Retinal fundus photograph. 2352x1568:
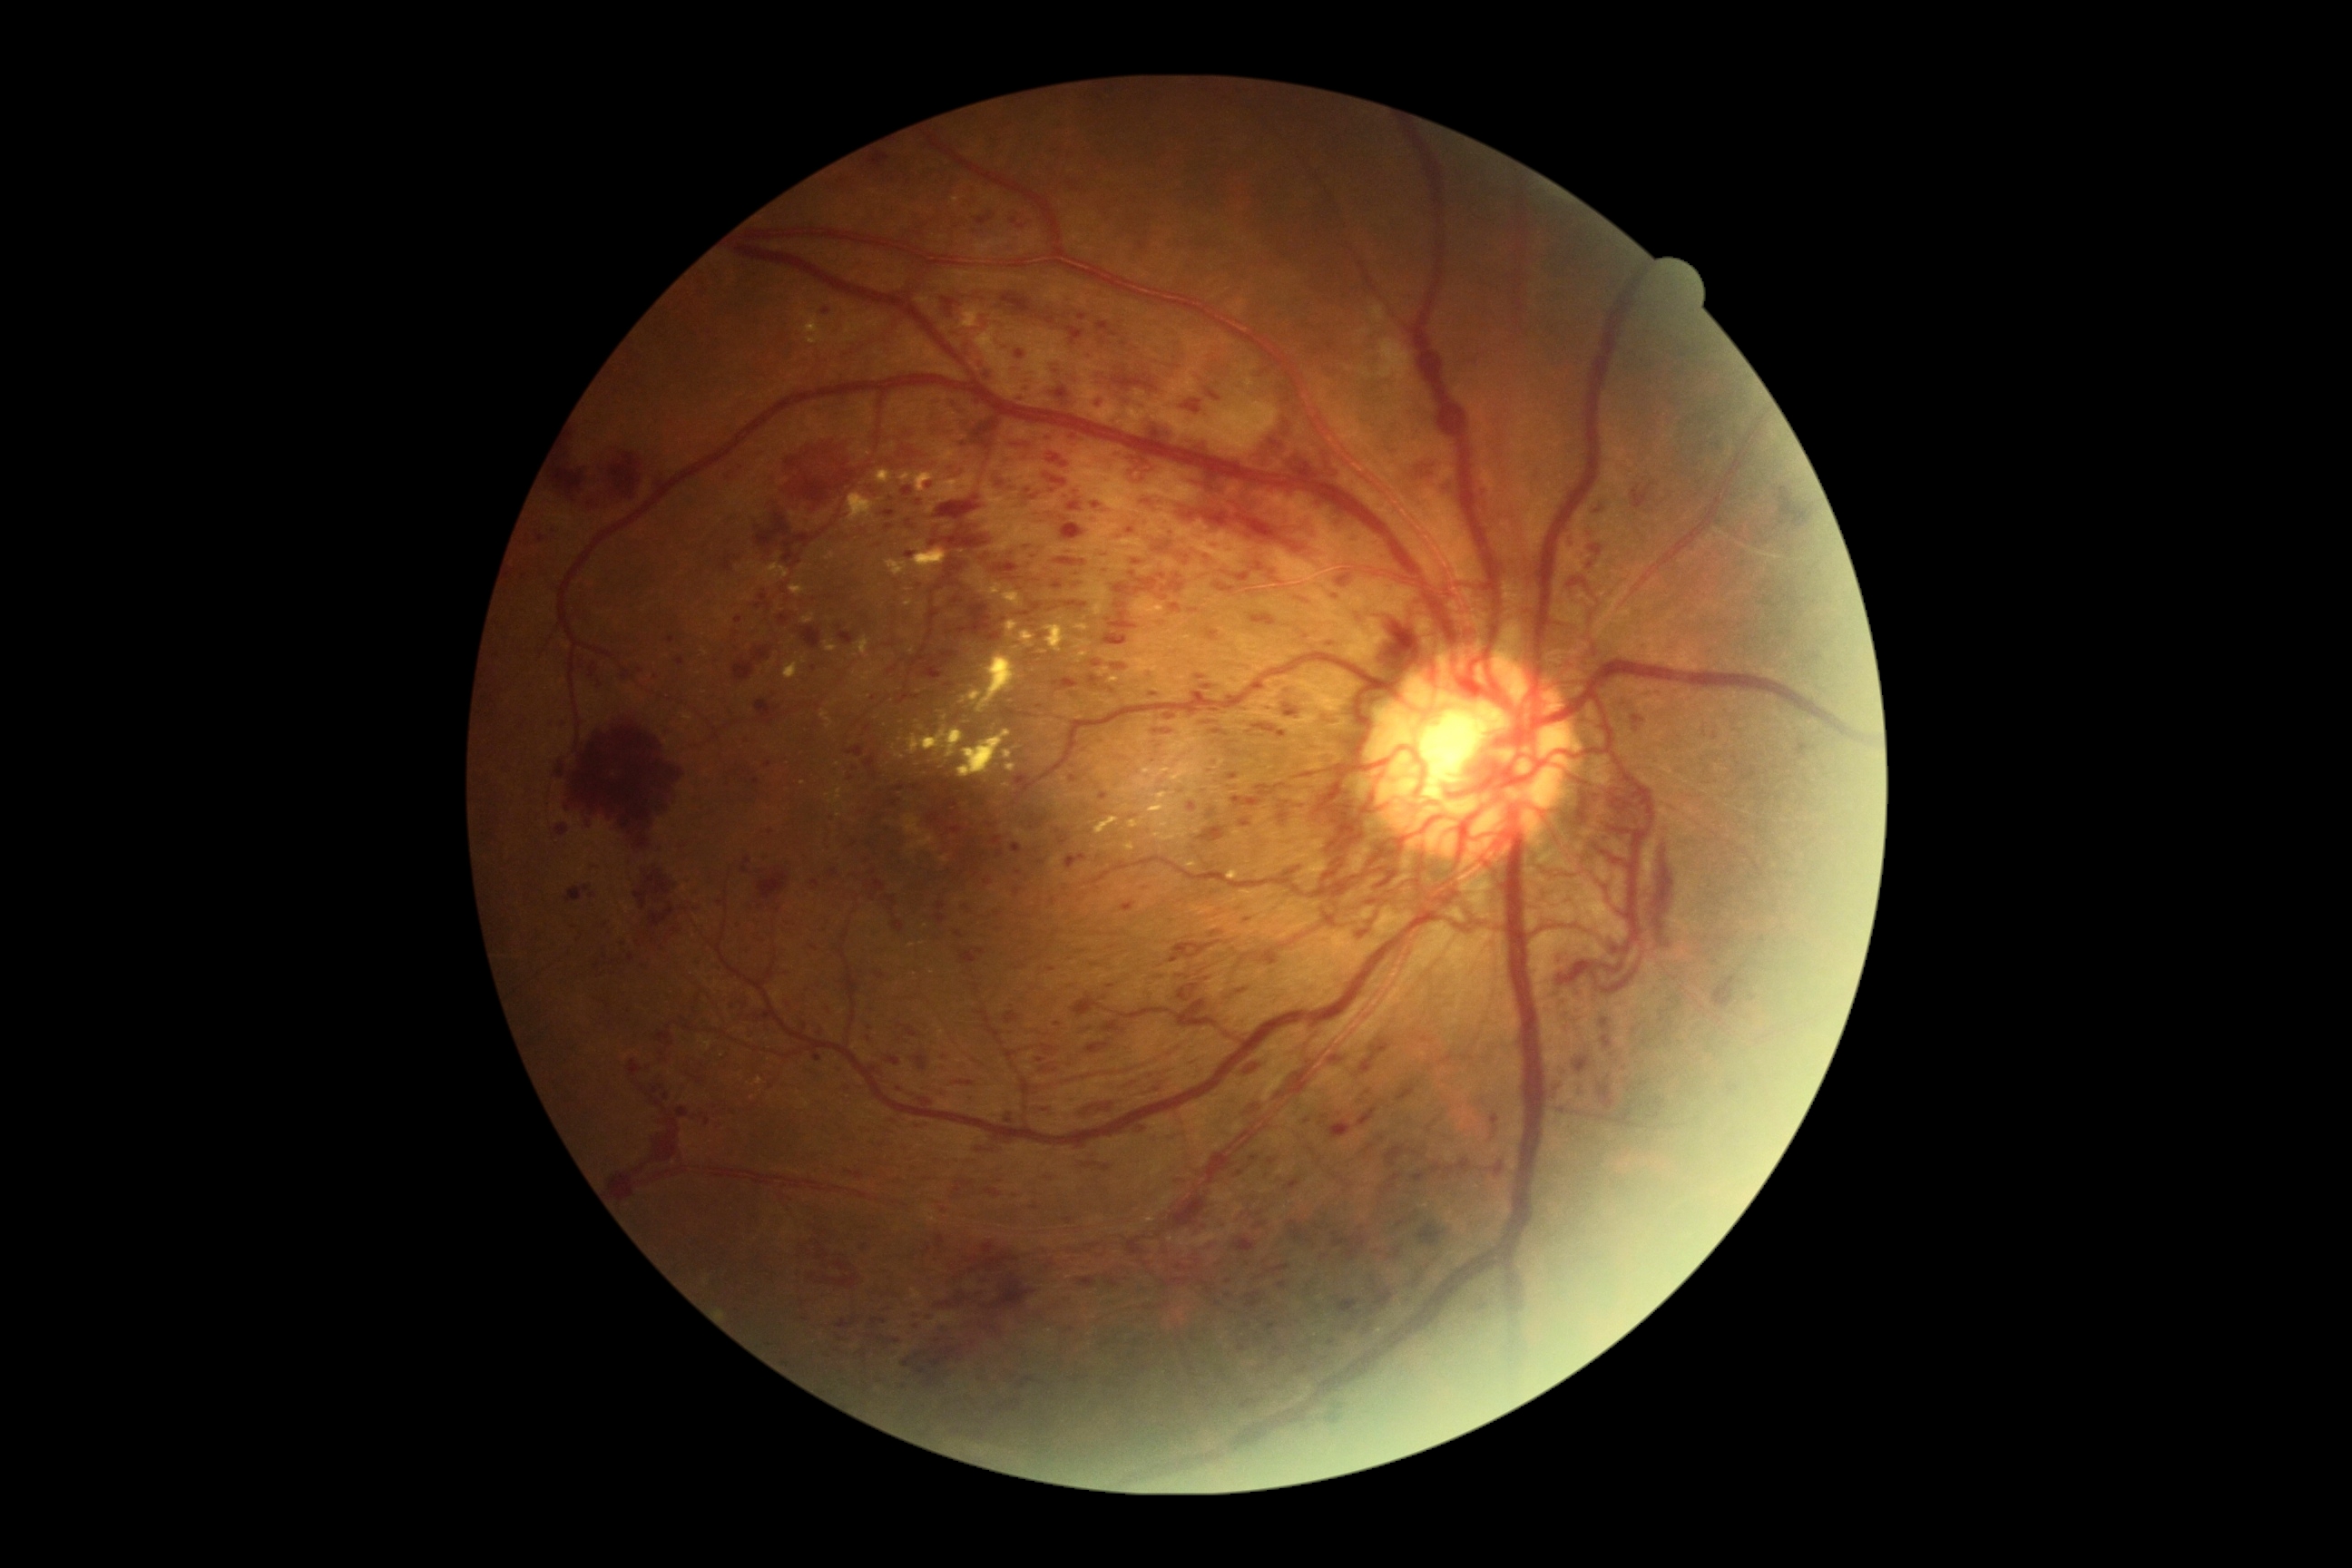
Diabetic retinopathy severity is proliferative diabetic retinopathy (grade 4) — neovascularization and/or vitreous/pre-retinal hemorrhage
Representative lesions:
* microaneurysms (subset): {"left": 1030, "top": 495, "right": 1039, "bottom": 502} | {"left": 1239, "top": 1346, "right": 1250, "bottom": 1353} | {"left": 1064, "top": 854, "right": 1088, "bottom": 870} | {"left": 1037, "top": 859, "right": 1046, "bottom": 865} | {"left": 667, "top": 638, "right": 676, "bottom": 643} | {"left": 888, "top": 799, "right": 901, "bottom": 807} | {"left": 936, "top": 903, "right": 946, "bottom": 912} | {"left": 936, "top": 914, "right": 946, "bottom": 925} | {"left": 1211, "top": 544, "right": 1222, "bottom": 549}
* Additional small microaneurysms near <pt>968,909</pt> | <pt>1101,1257</pt> | <pt>853,778</pt> | <pt>814,669</pt> | <pt>984,856</pt> | <pt>989,884</pt> | <pt>605,957</pt> | <pt>1046,1110</pt>
* hard exudates (subset): {"left": 961, "top": 691, "right": 983, "bottom": 703} | {"left": 899, "top": 471, "right": 939, "bottom": 493} | {"left": 926, "top": 473, "right": 977, "bottom": 504} | {"left": 1186, "top": 861, "right": 1197, "bottom": 868} | {"left": 977, "top": 328, "right": 997, "bottom": 349} | {"left": 700, "top": 1037, "right": 714, "bottom": 1052} | {"left": 1161, "top": 605, "right": 1164, "bottom": 614} | {"left": 992, "top": 582, "right": 1028, "bottom": 611} | {"left": 758, "top": 564, "right": 790, "bottom": 582} | {"left": 803, "top": 614, "right": 816, "bottom": 625} | {"left": 1155, "top": 827, "right": 1188, "bottom": 841} | {"left": 887, "top": 560, "right": 910, "bottom": 576} | {"left": 790, "top": 585, "right": 807, "bottom": 596} | {"left": 959, "top": 730, "right": 1012, "bottom": 779} | {"left": 1228, "top": 870, "right": 1239, "bottom": 881} | {"left": 1006, "top": 763, "right": 1017, "bottom": 772}
* Additional small hard exudates near <pt>957,200</pt>
* hemorrhages (subset): {"left": 966, "top": 1242, "right": 1019, "bottom": 1275} | {"left": 589, "top": 662, "right": 598, "bottom": 680} | {"left": 1055, "top": 558, "right": 1086, "bottom": 567} | {"left": 1102, "top": 1269, "right": 1126, "bottom": 1291} | {"left": 1146, "top": 418, "right": 1173, "bottom": 444} | {"left": 1329, "top": 1121, "right": 1353, "bottom": 1139} | {"left": 778, "top": 614, "right": 792, "bottom": 627} | {"left": 1019, "top": 603, "right": 1043, "bottom": 618} | {"left": 776, "top": 972, "right": 798, "bottom": 983} | {"left": 1052, "top": 580, "right": 1064, "bottom": 591} | {"left": 629, "top": 954, "right": 638, "bottom": 963} | {"left": 1413, "top": 1280, "right": 1418, "bottom": 1288} | {"left": 1251, "top": 1155, "right": 1259, "bottom": 1162} | {"left": 573, "top": 730, "right": 674, "bottom": 852} | {"left": 887, "top": 1338, "right": 901, "bottom": 1346} | {"left": 921, "top": 651, "right": 959, "bottom": 680} | {"left": 752, "top": 779, "right": 761, "bottom": 787}
* Additional small hemorrhages near <pt>916,1327</pt> | <pt>837,1351</pt>